Wide-field fundus image from infant ROP screening; 640 by 480 pixels: 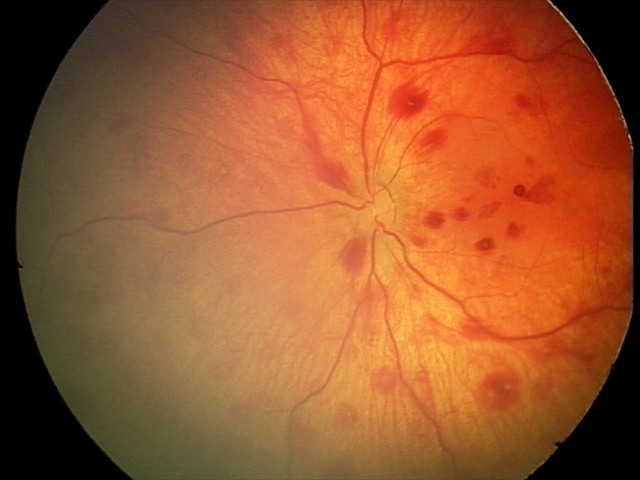

Finding: retinal hemorrhages.